Color fundus image:
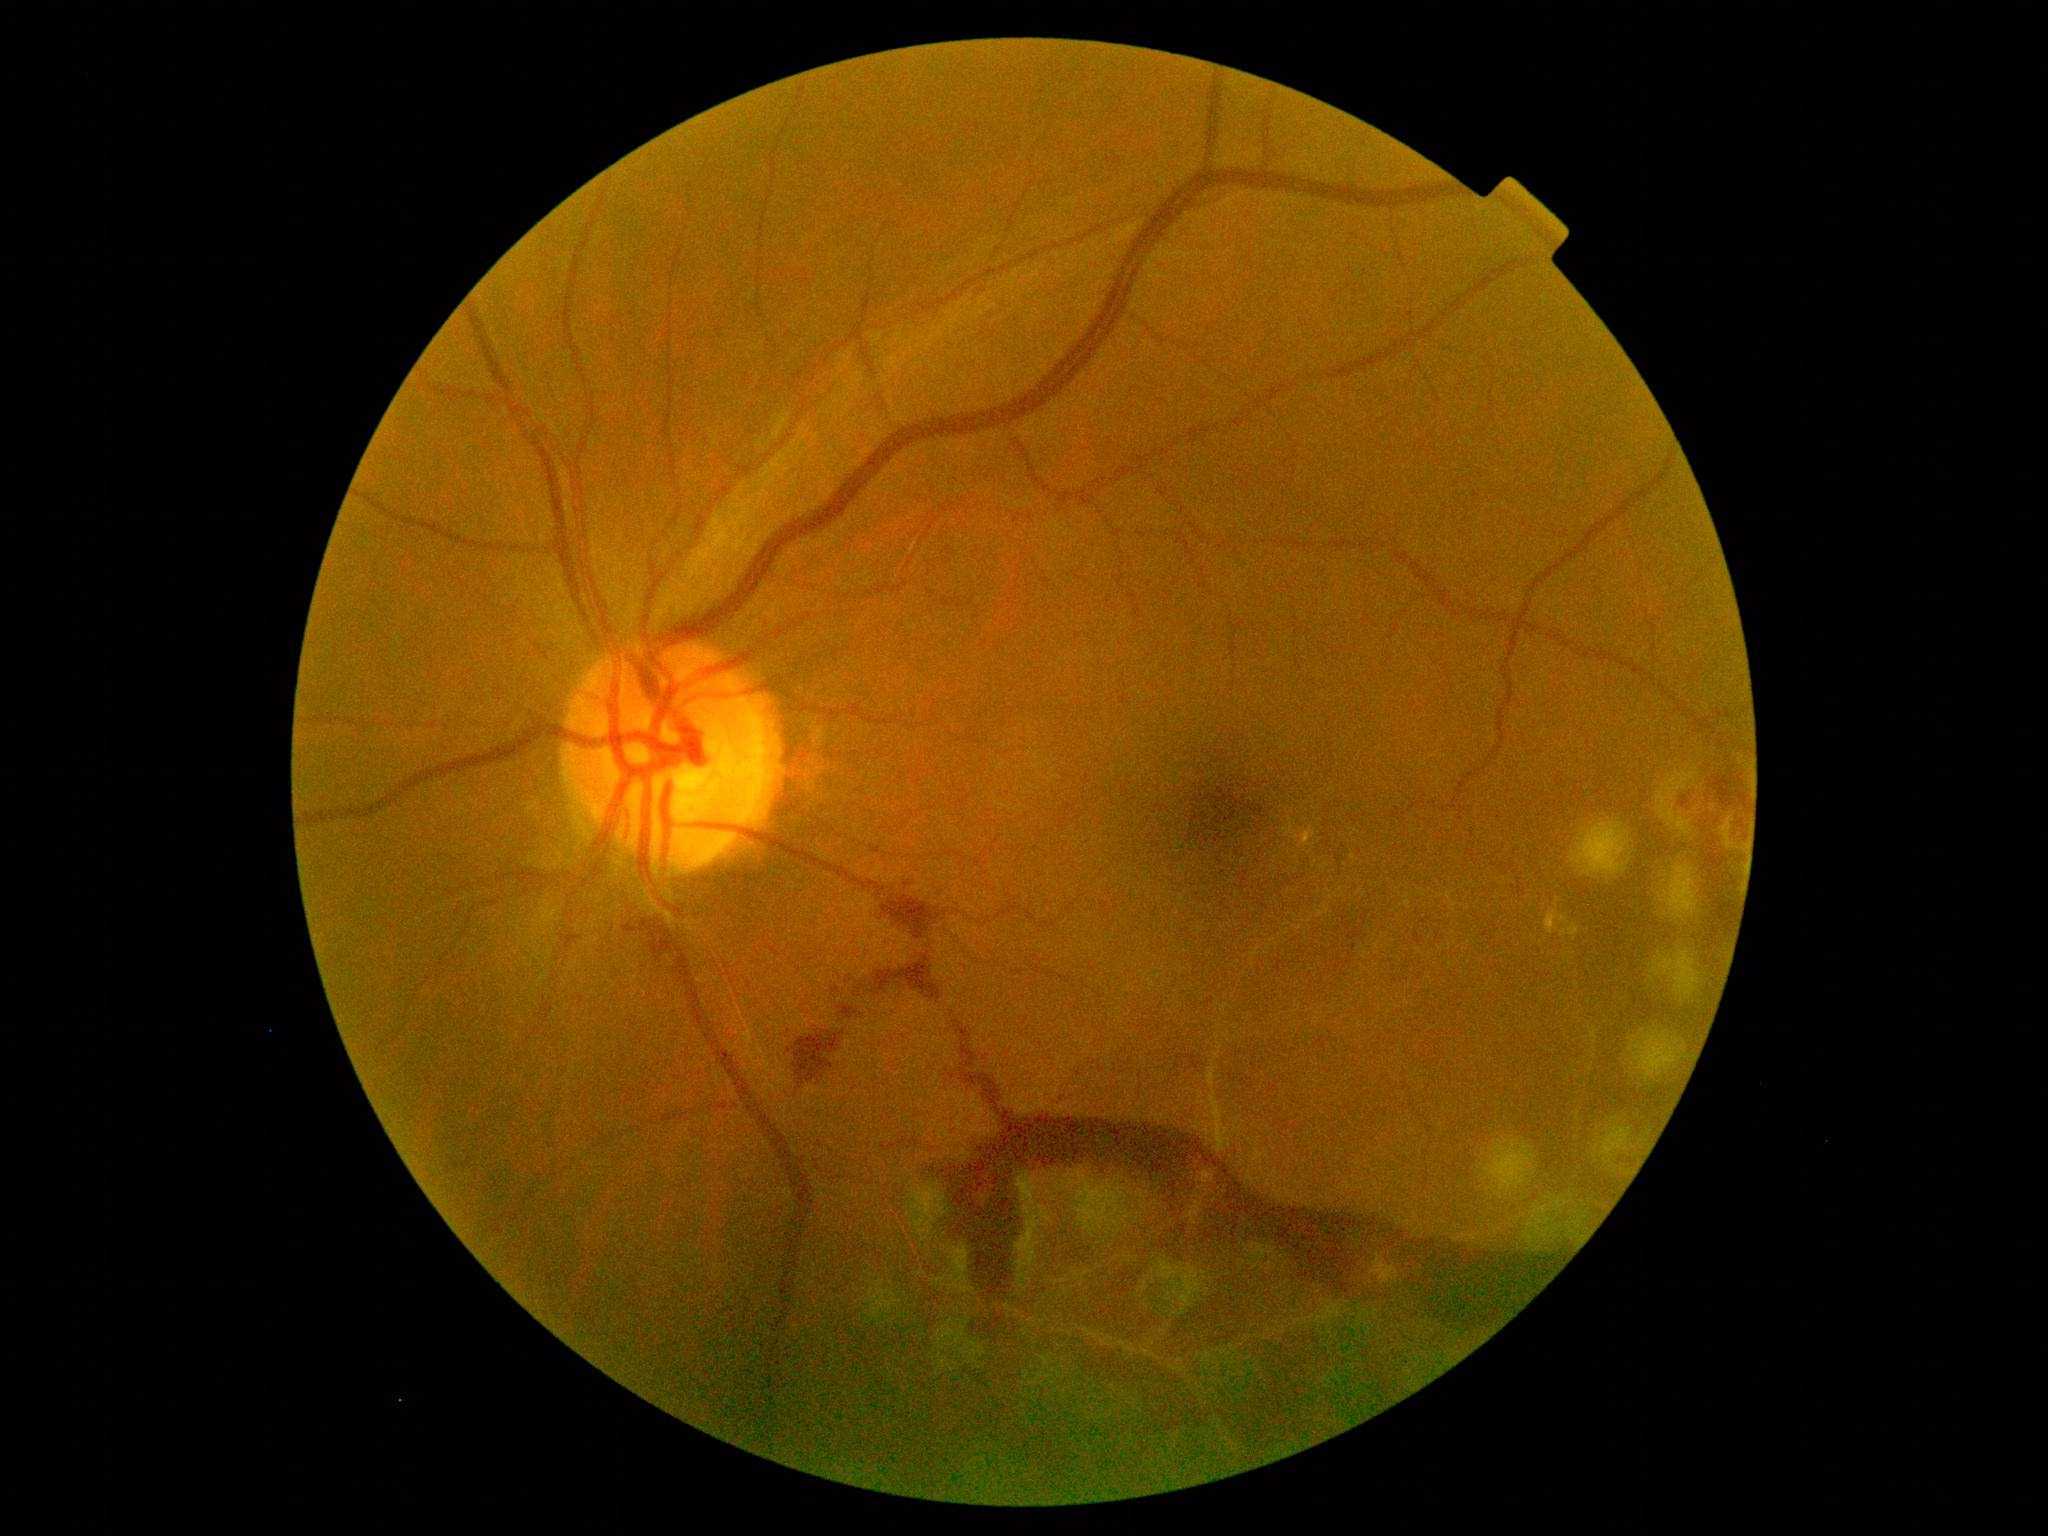

Findings:
• retinopathy grade — 4